Acquired on the Natus RetCam Envision · 1440x1080 · RetCam wide-field infant fundus image:
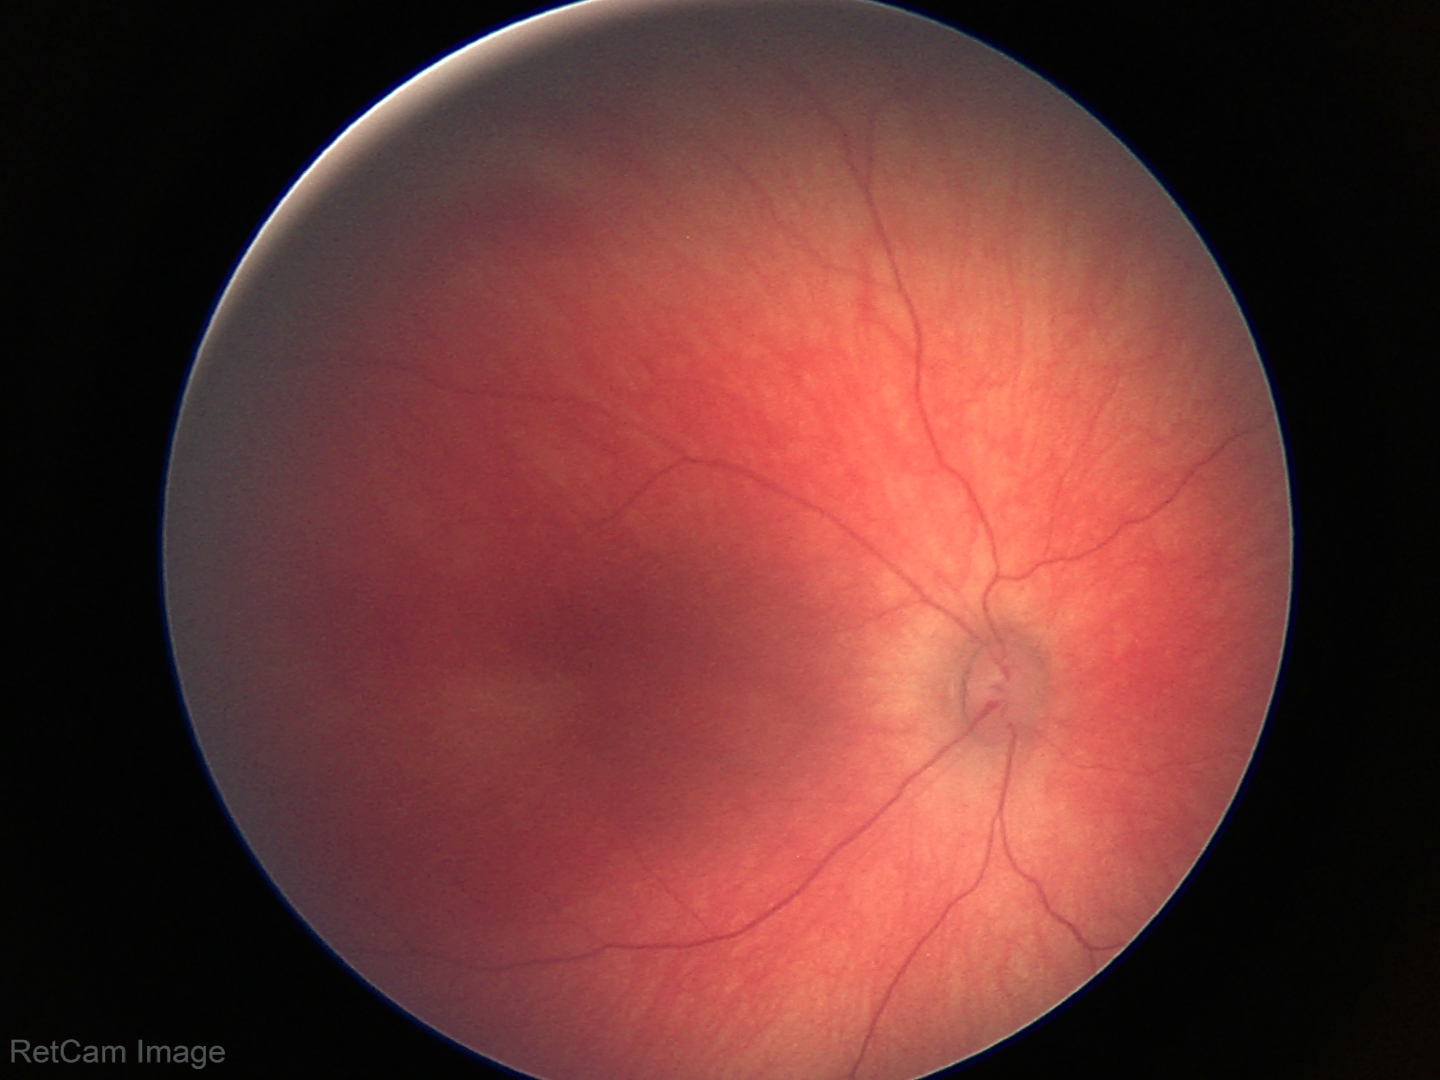

Screening examination diagnosed as physiological.